512x512. Retinal fundus photograph: 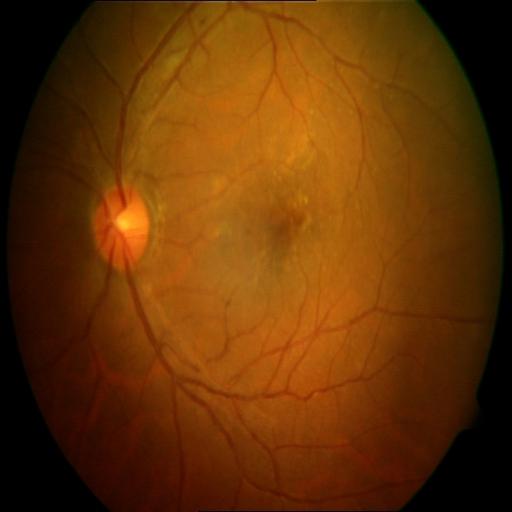
The image shows age-related macular degeneration.